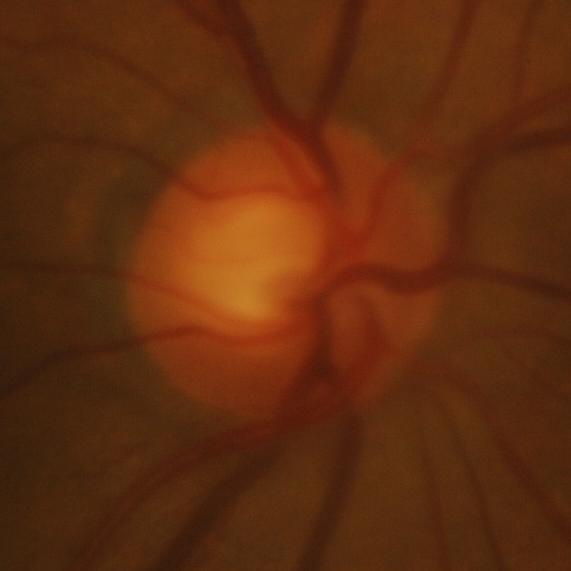
Finding: glaucomatous damage to the optic nerve.